Phoenix ICON, 100° FOV; wide-field fundus image from infant ROP screening; 1240 by 1240 pixels: 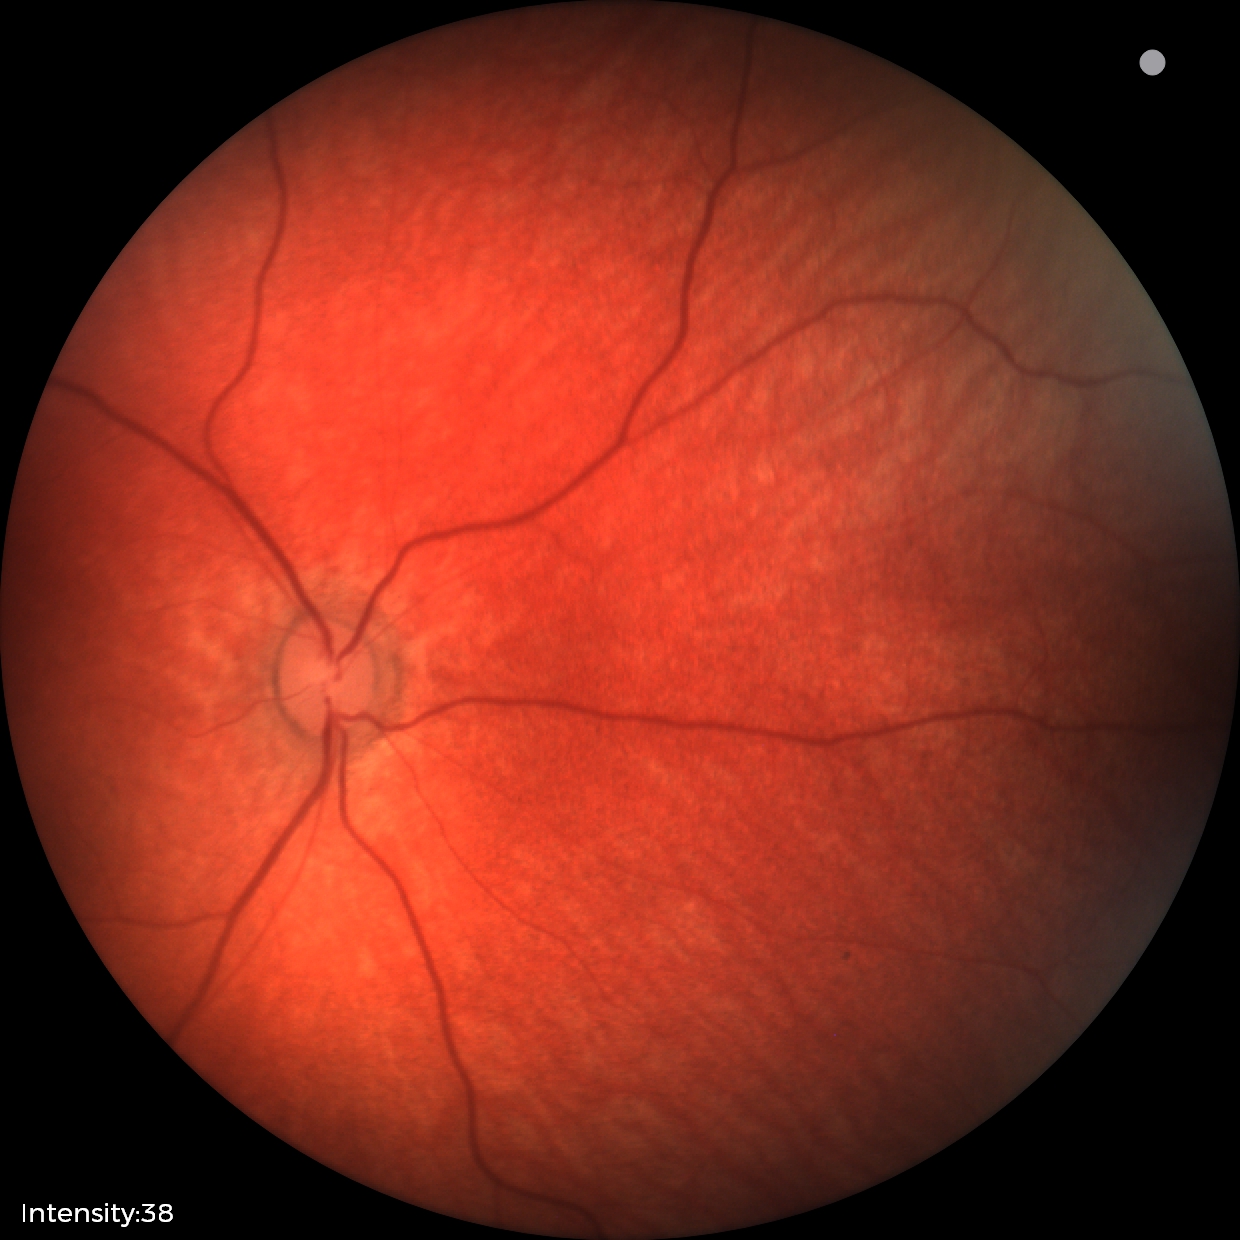
Impression = normal retinal appearance.